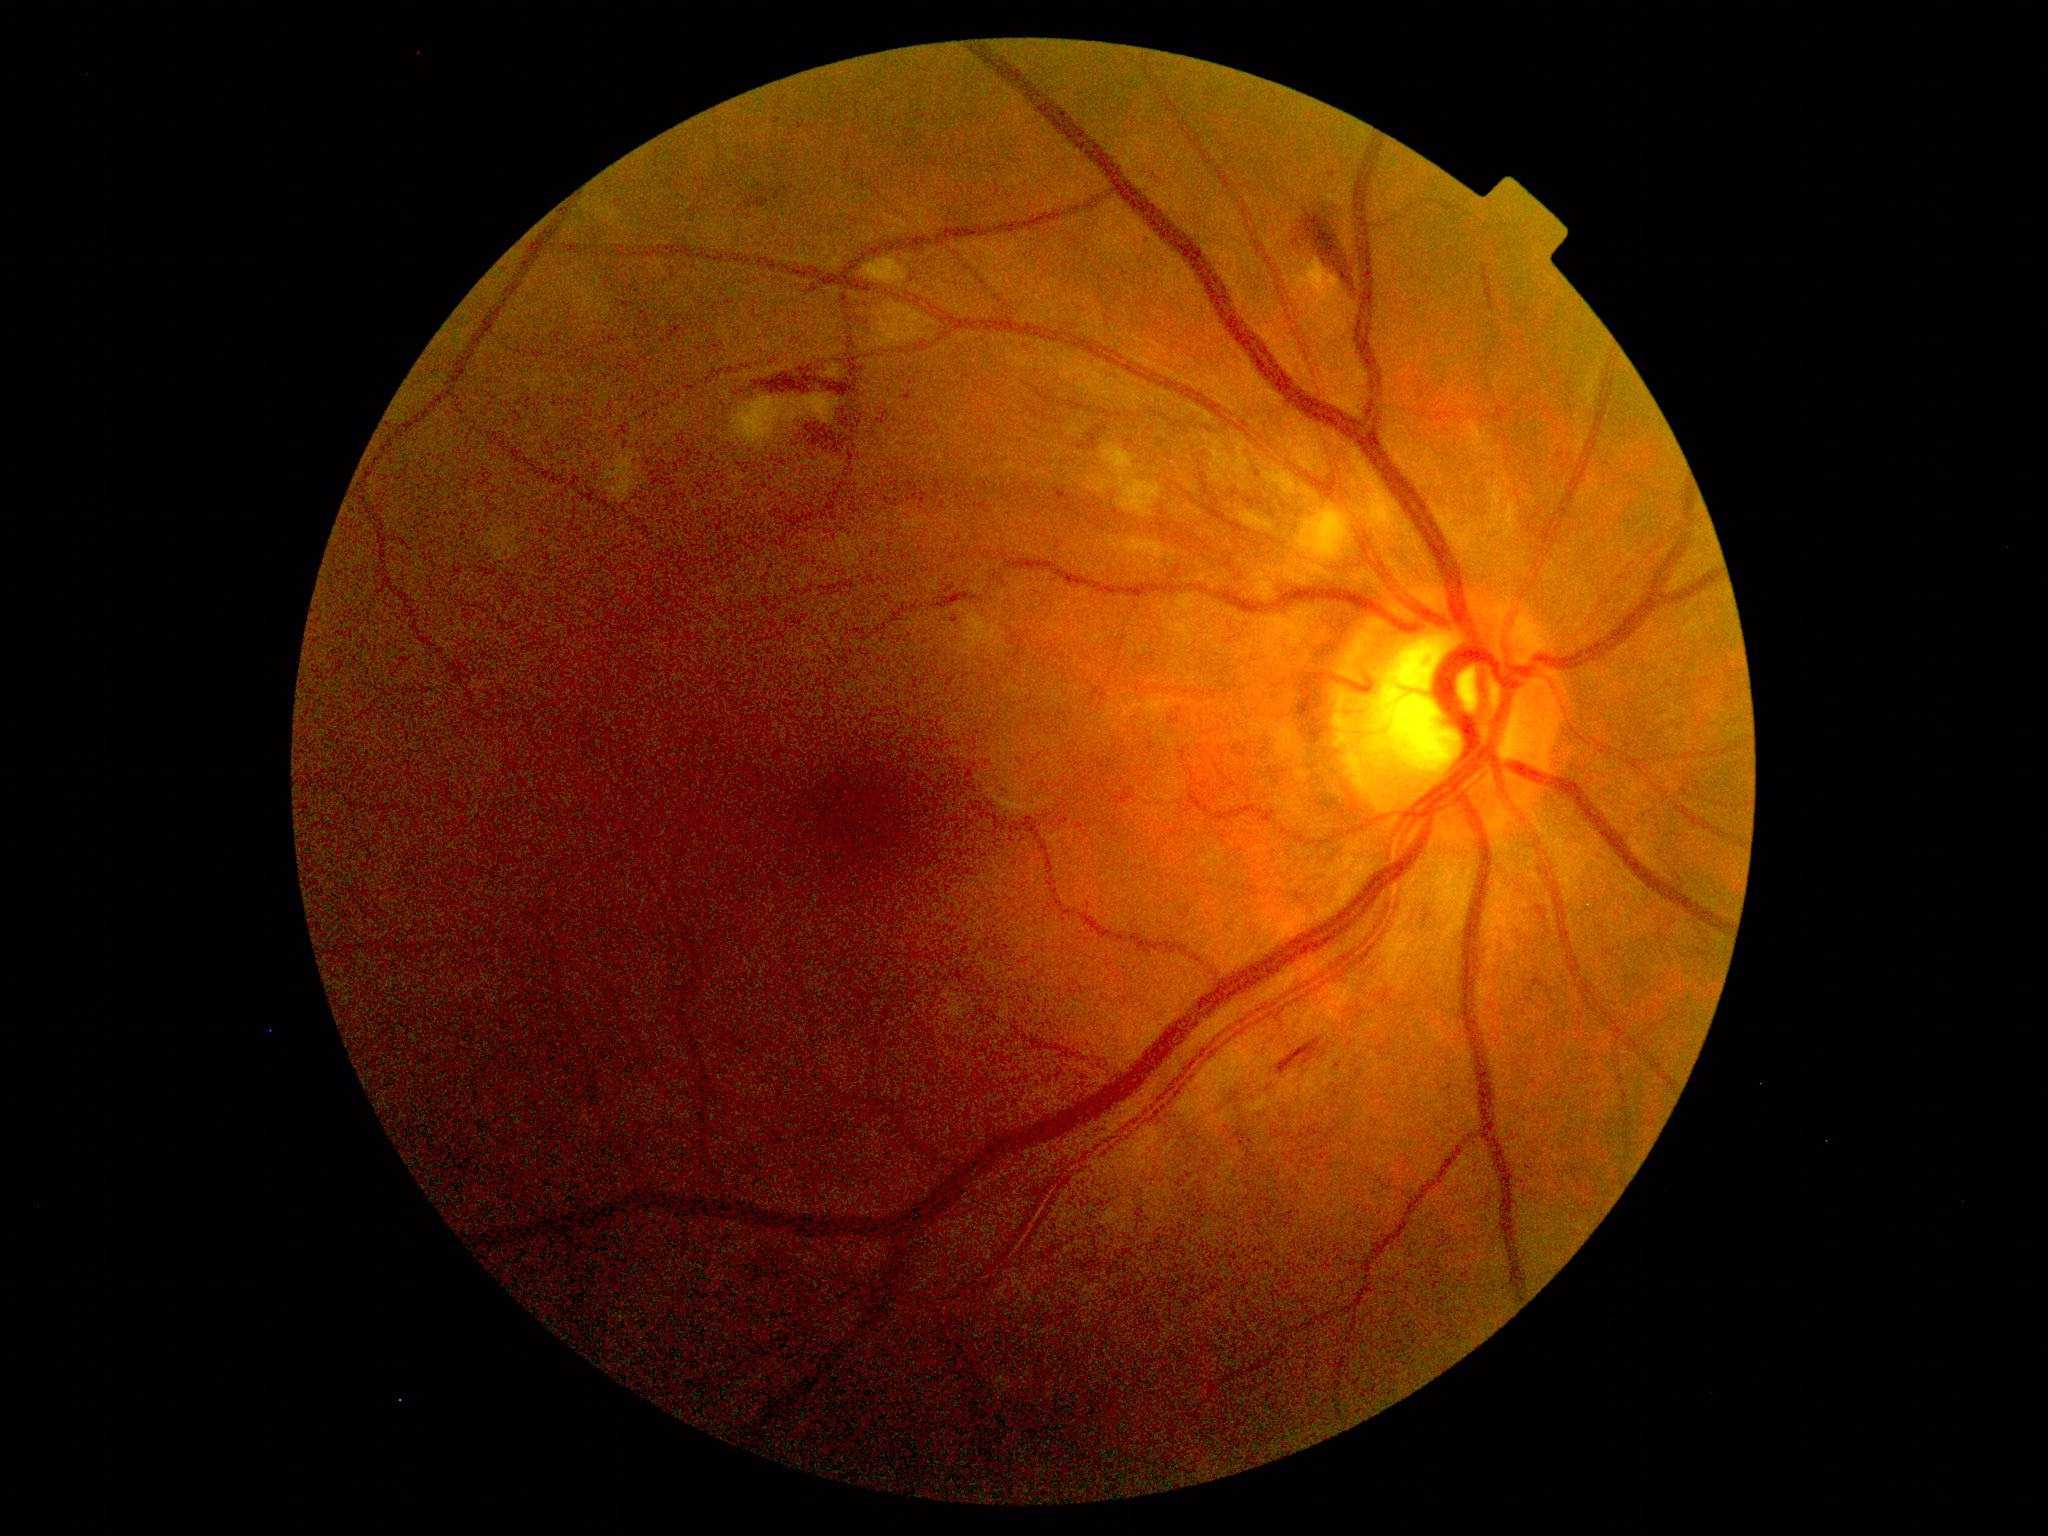

dr_category: non-proliferative diabetic retinopathy
dr_grade: 2 (moderate NPDR)